45° FOV
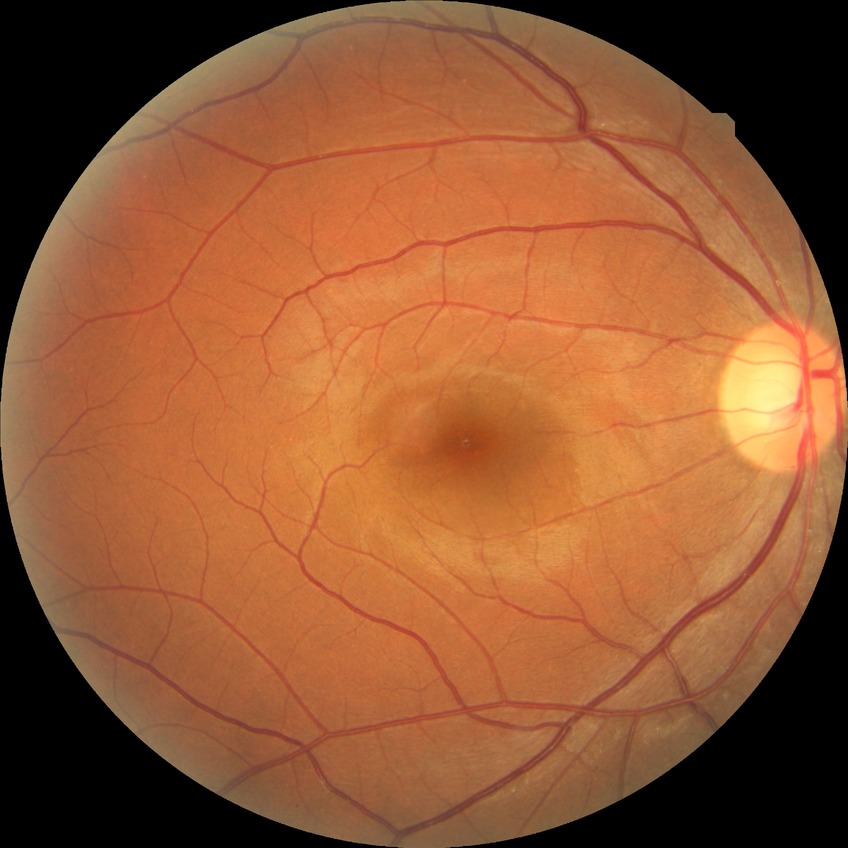 Modified Davis grading is no diabetic retinopathy.